Nonmydriatic fundus photograph · DR severity per modified Davis staging · CFP:
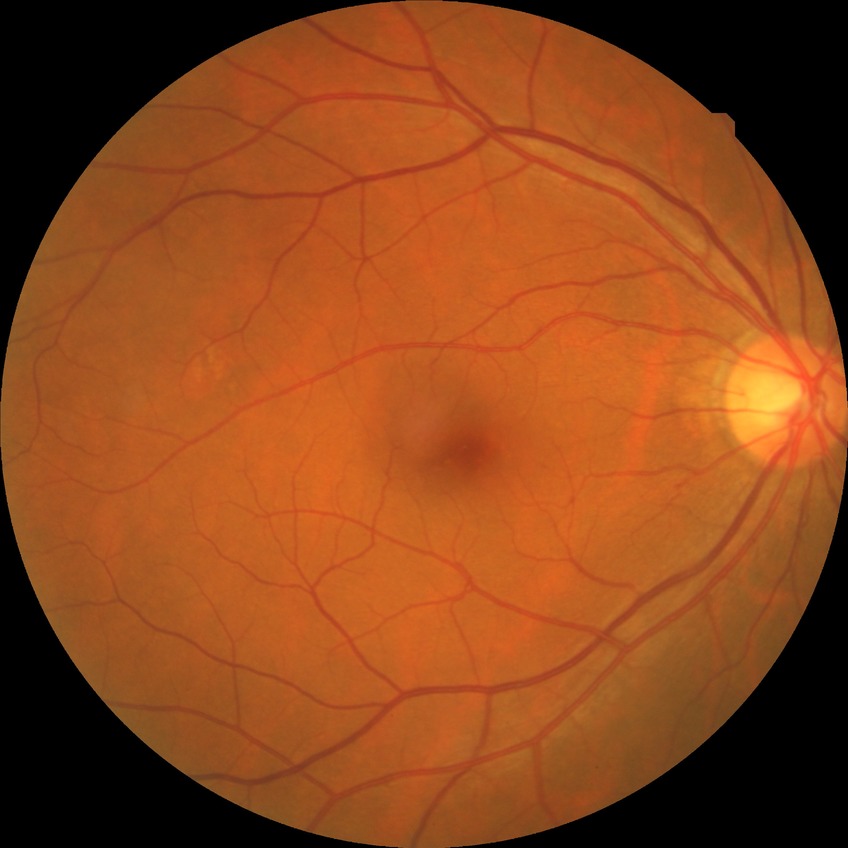 diabetic retinopathy (DR) = no diabetic retinopathy (NDR)